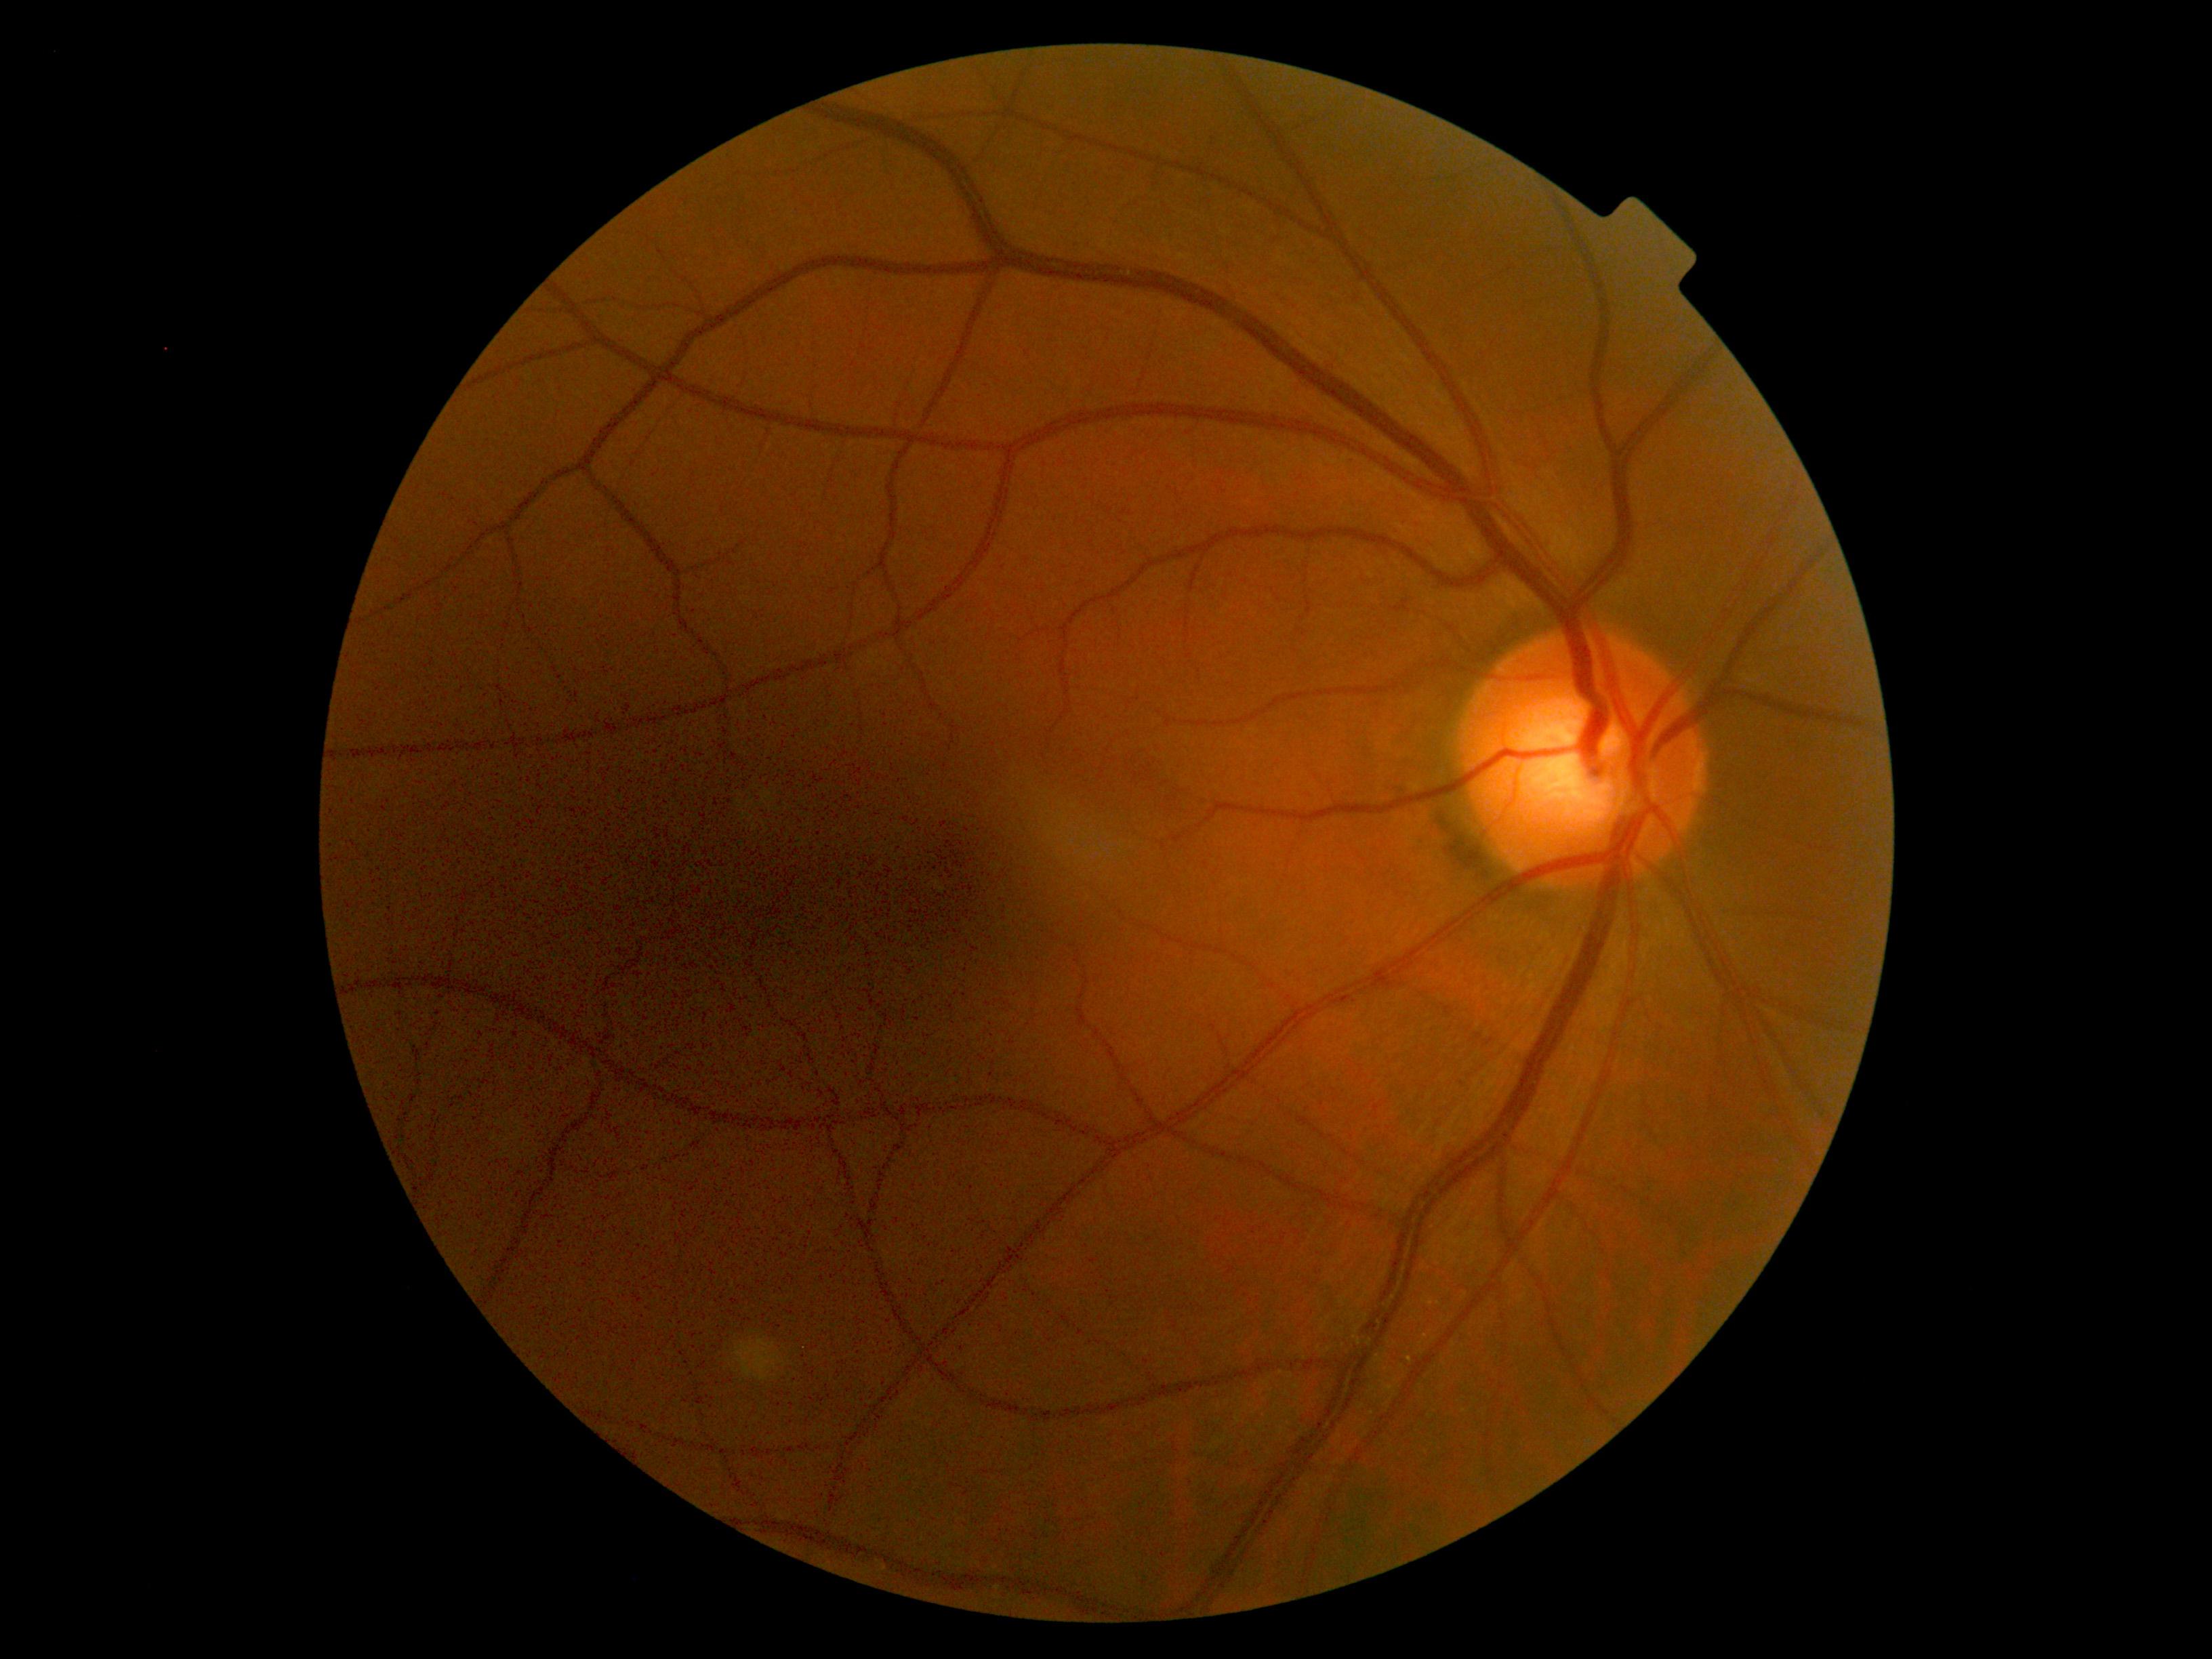
Findings:
* DR — grade 0 (no apparent retinopathy) — no visible signs of diabetic retinopathy